45° FOV. Retinal fundus photograph. 2352 x 1568 pixels:
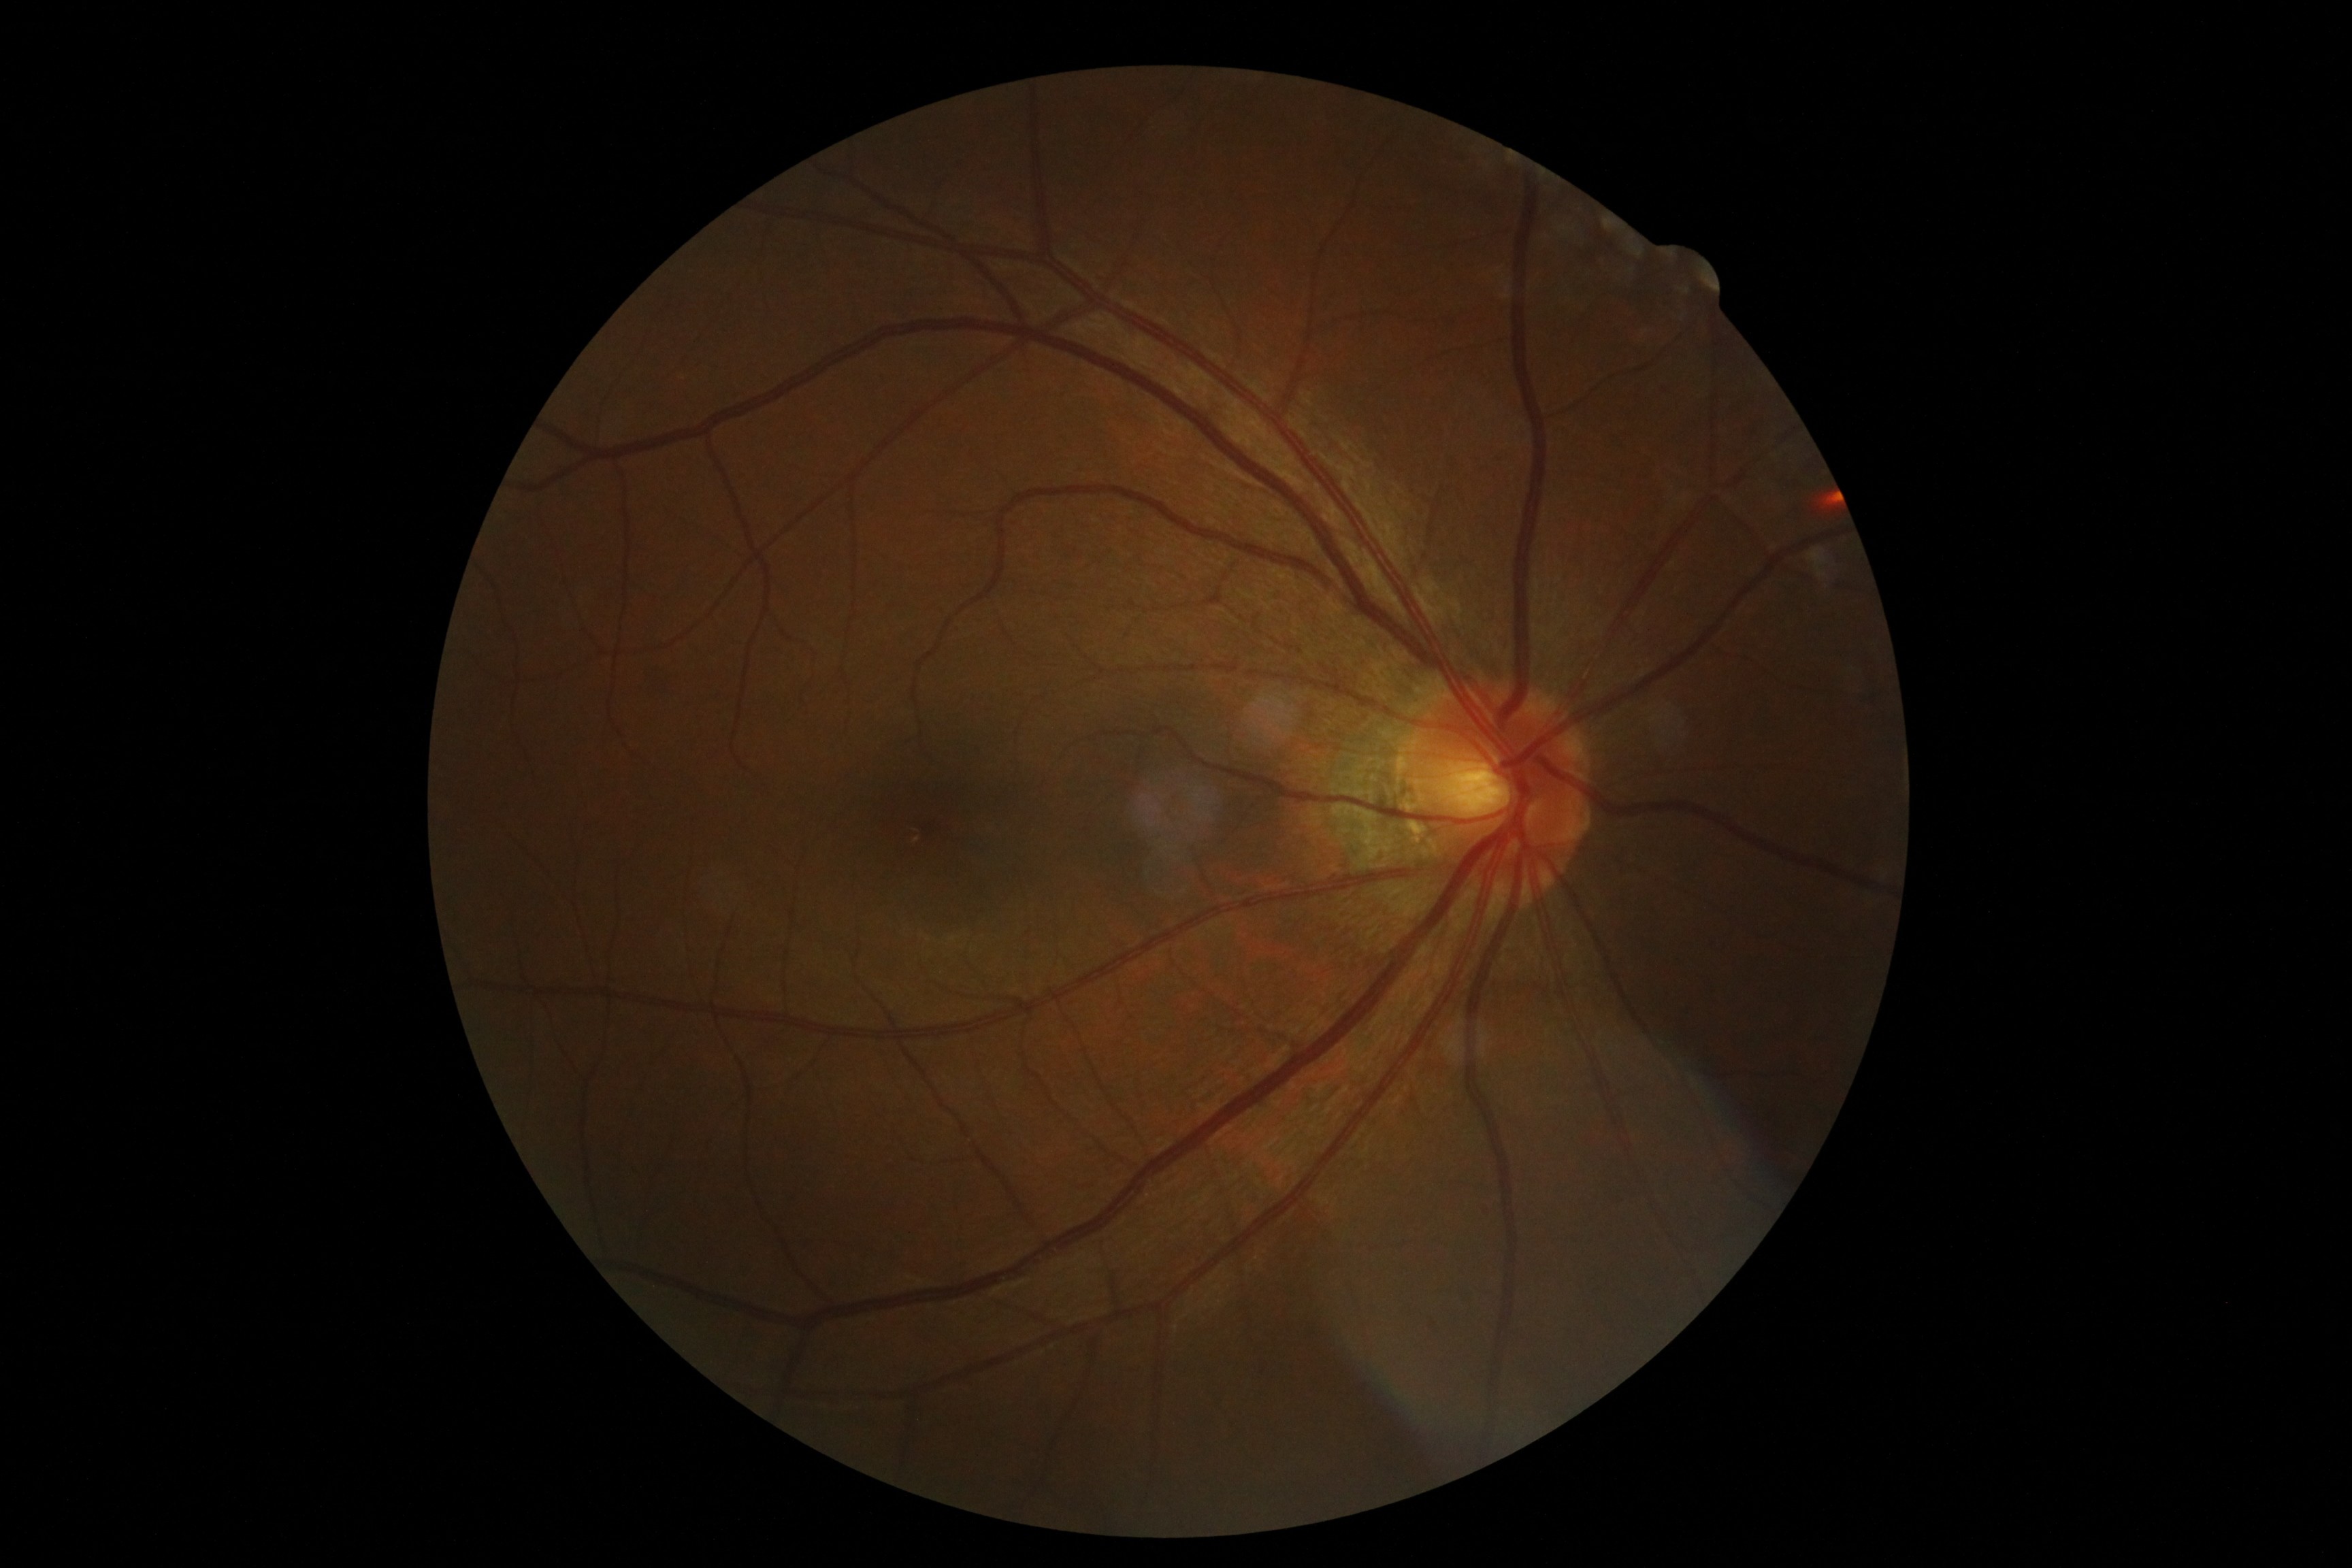

No signs of diabetic retinopathy. DR is no apparent diabetic retinopathy (grade 0).